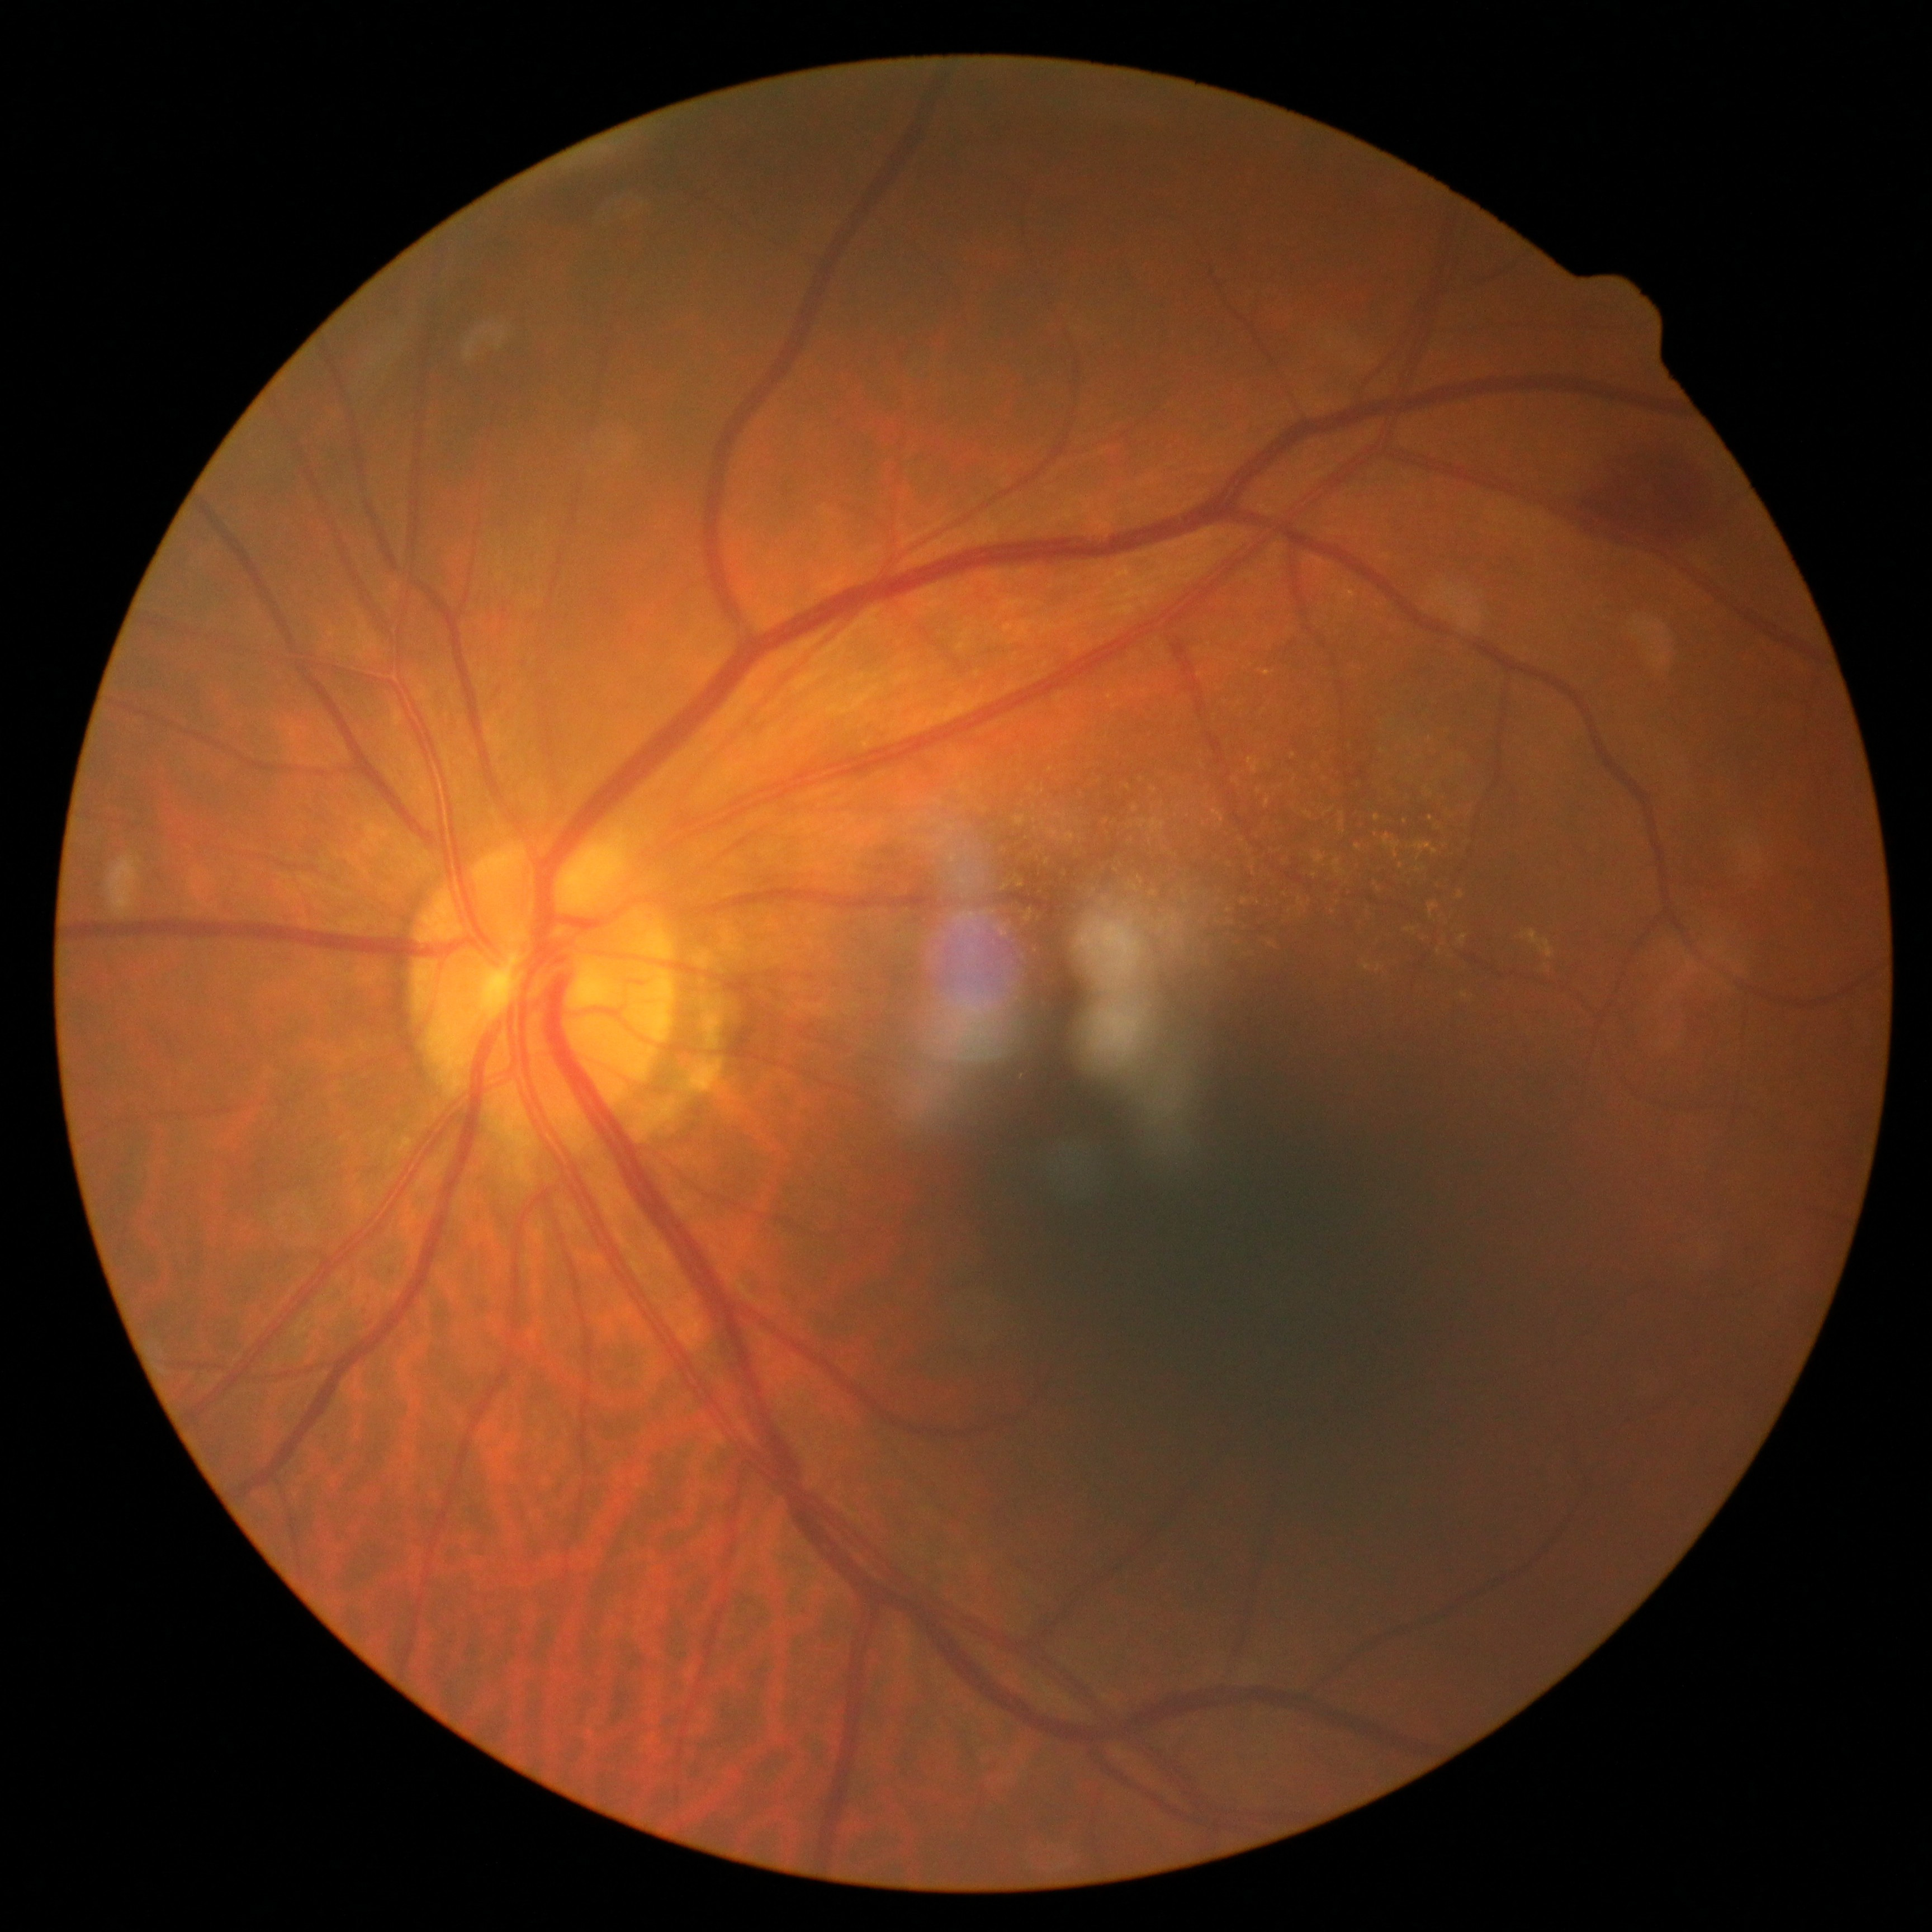

DR is 2 — more than just microaneurysms but less than severe NPDR.